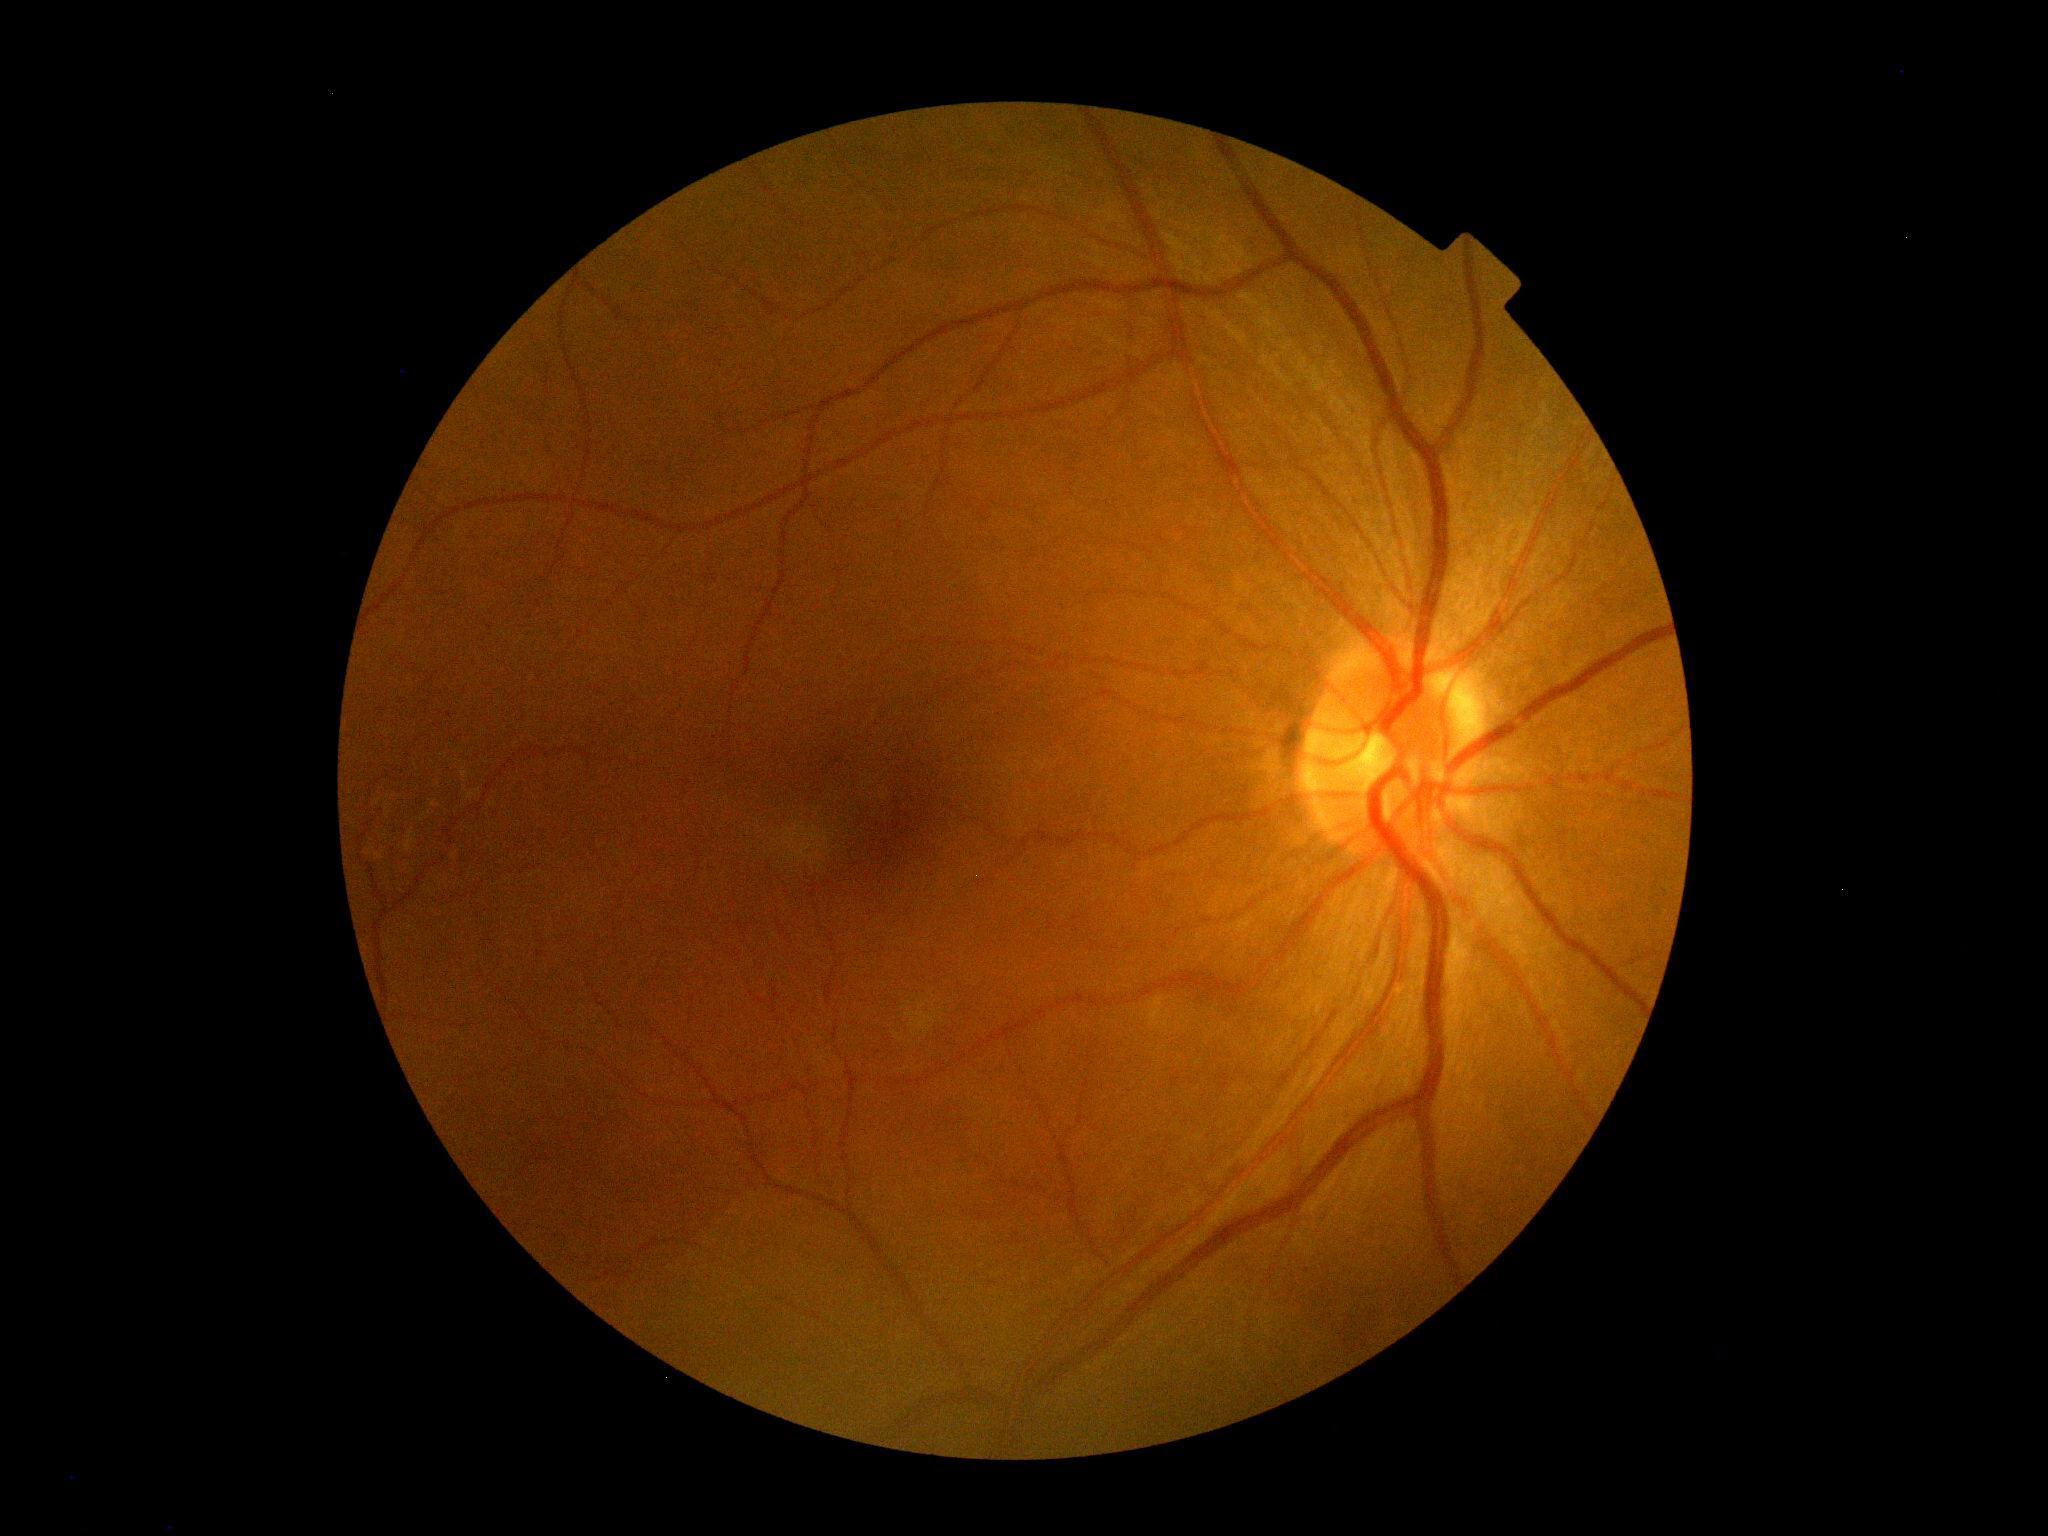
Diabetic retinopathy (DR): 0 — no visible signs of diabetic retinopathy.